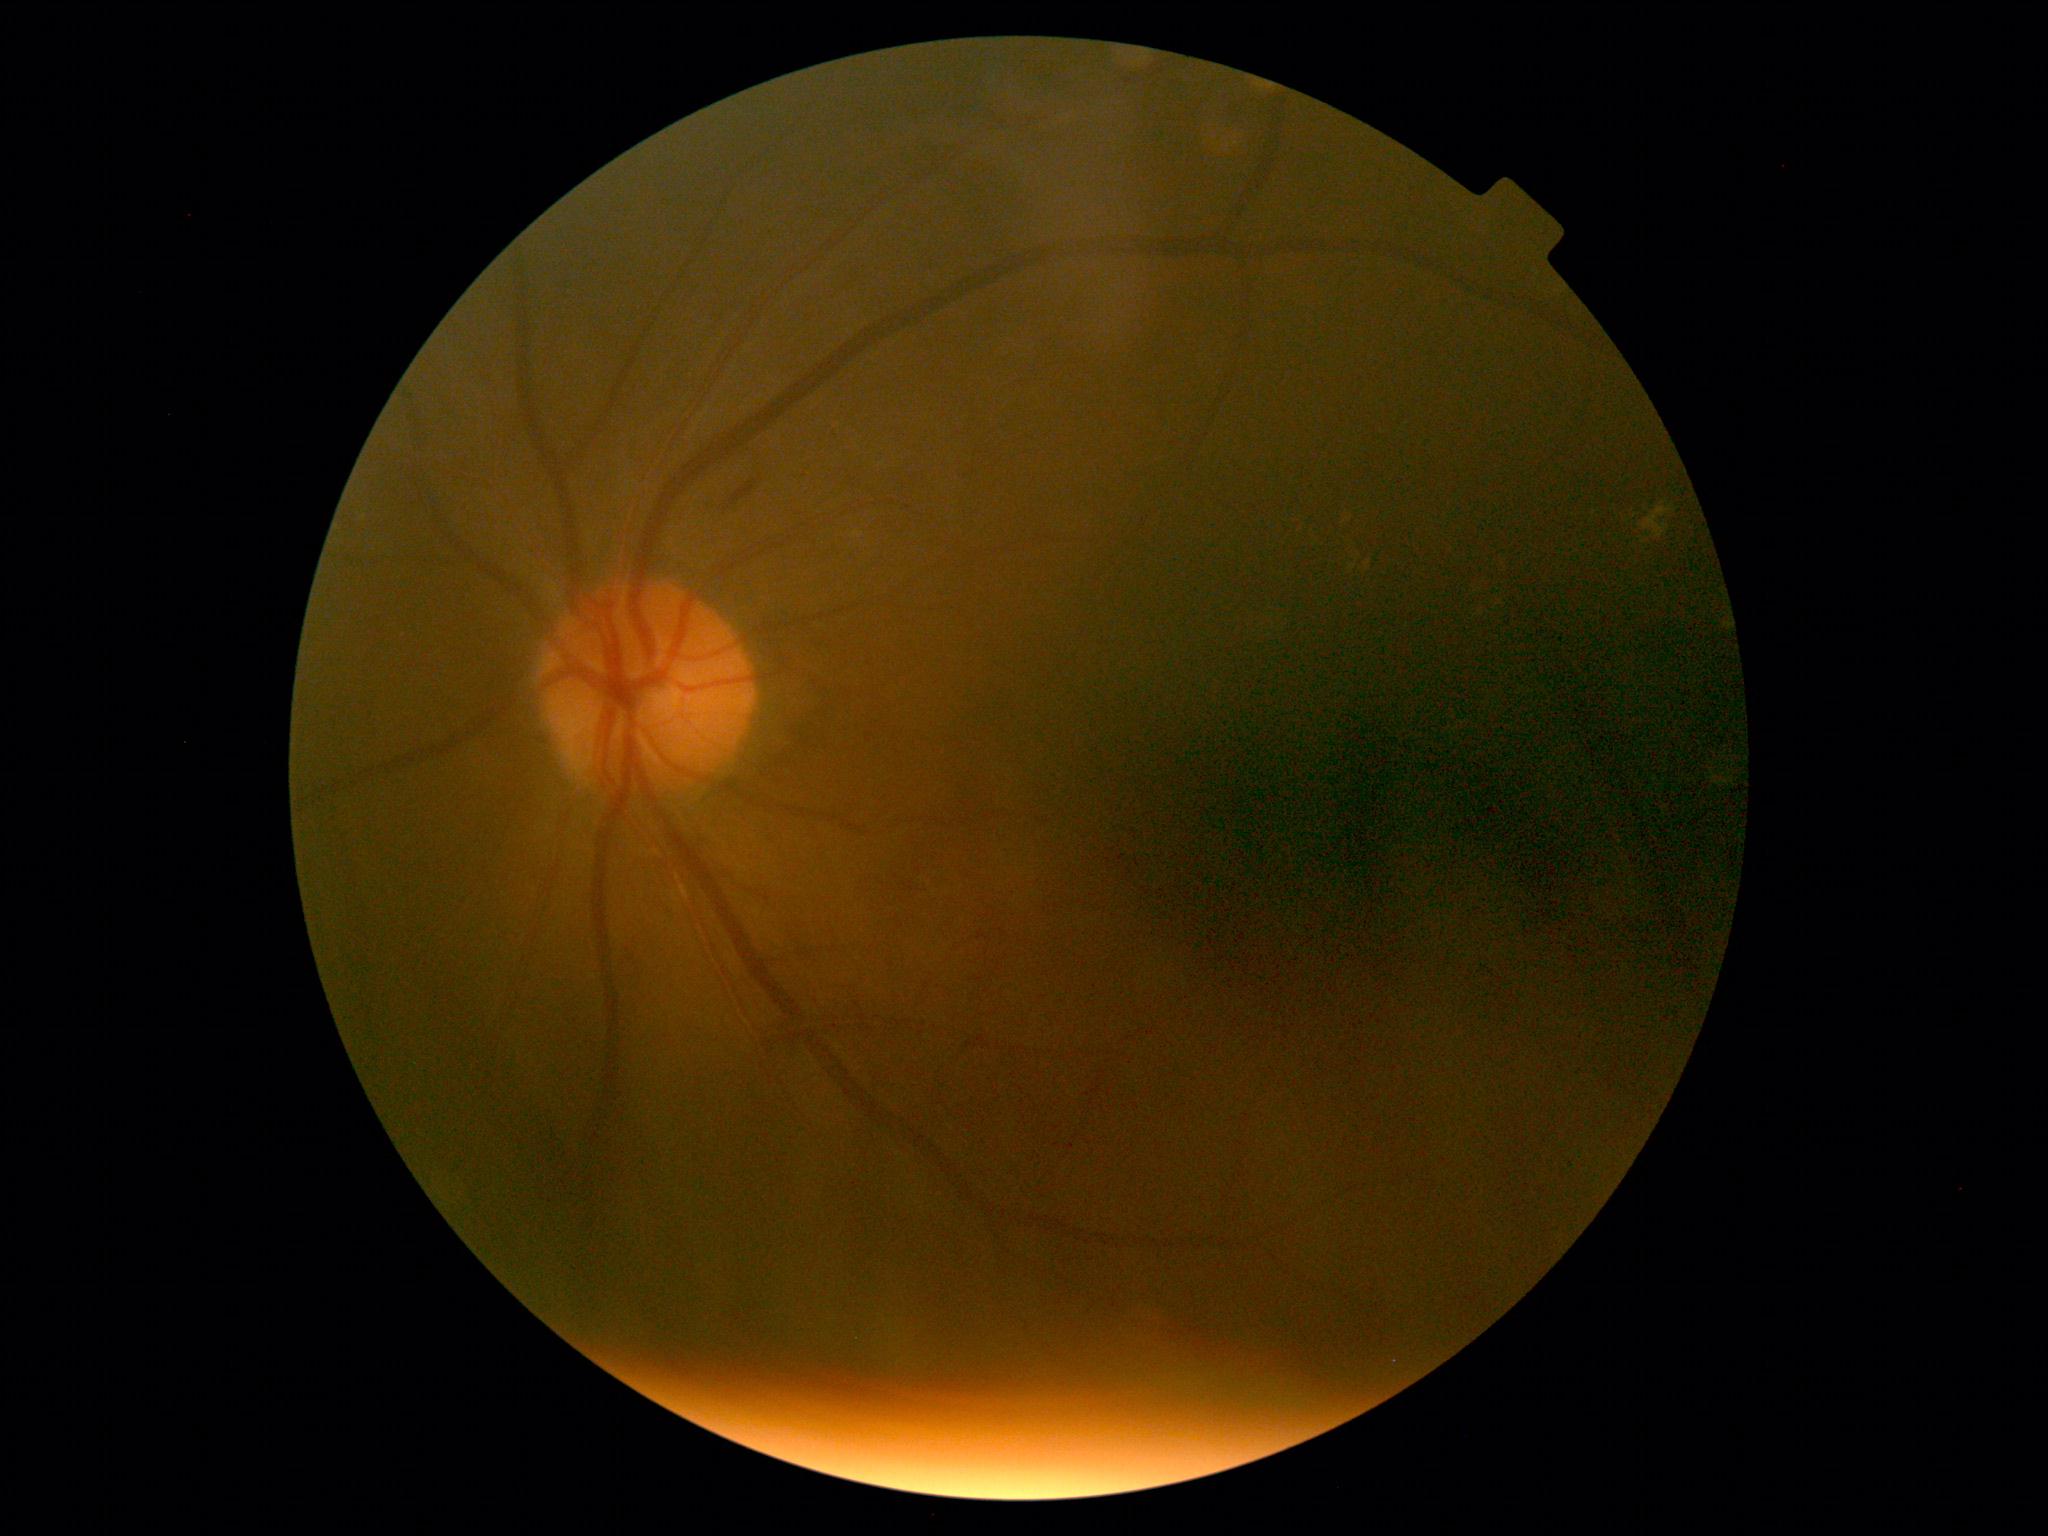
Annotations:
• DR: grade 2